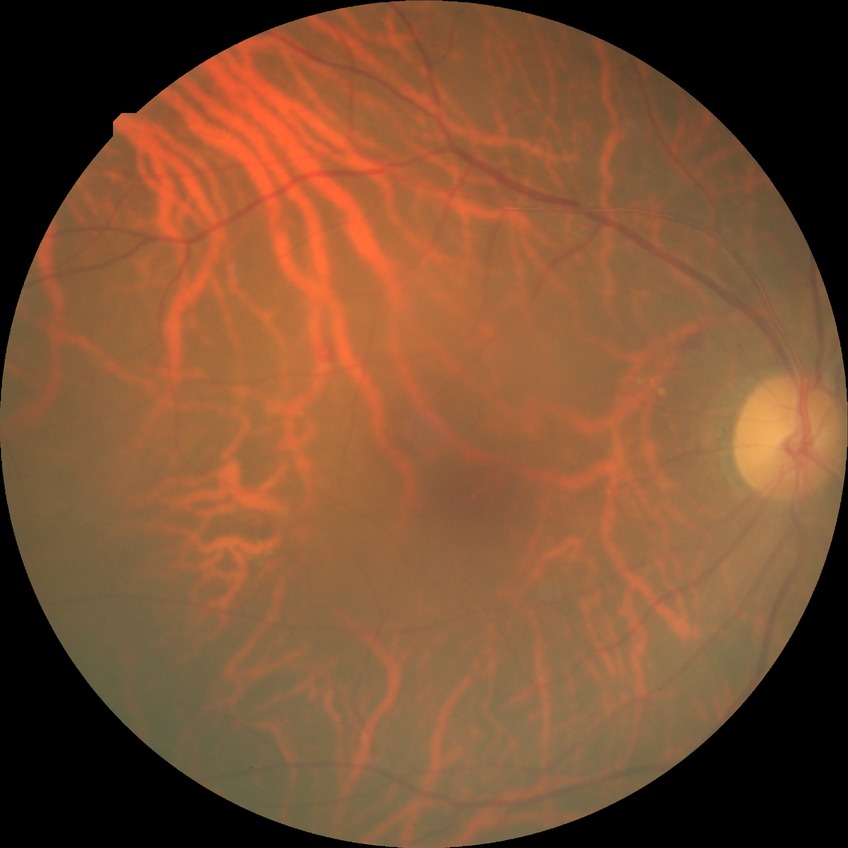

Diabetic retinopathy severity: simple diabetic retinopathy.